130° field of view (Clarity RetCam 3) · pediatric retinal photograph (wide-field):
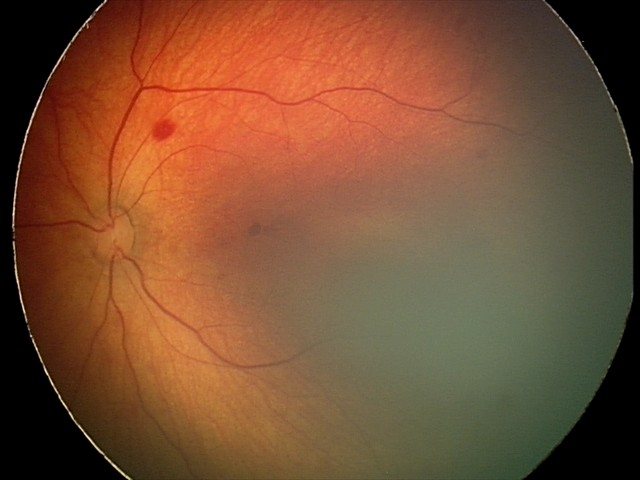
Screening diagnosis = retinal hemorrhages.